CFP: 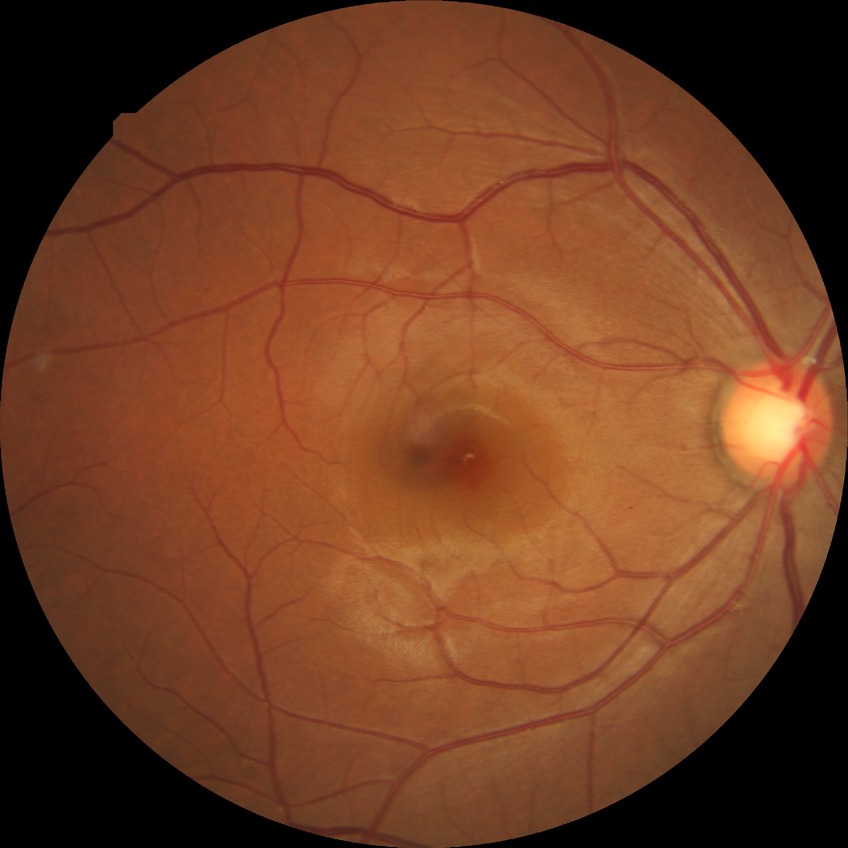

Findings:
• diabetic retinopathy severity: pre-proliferative diabetic retinopathy